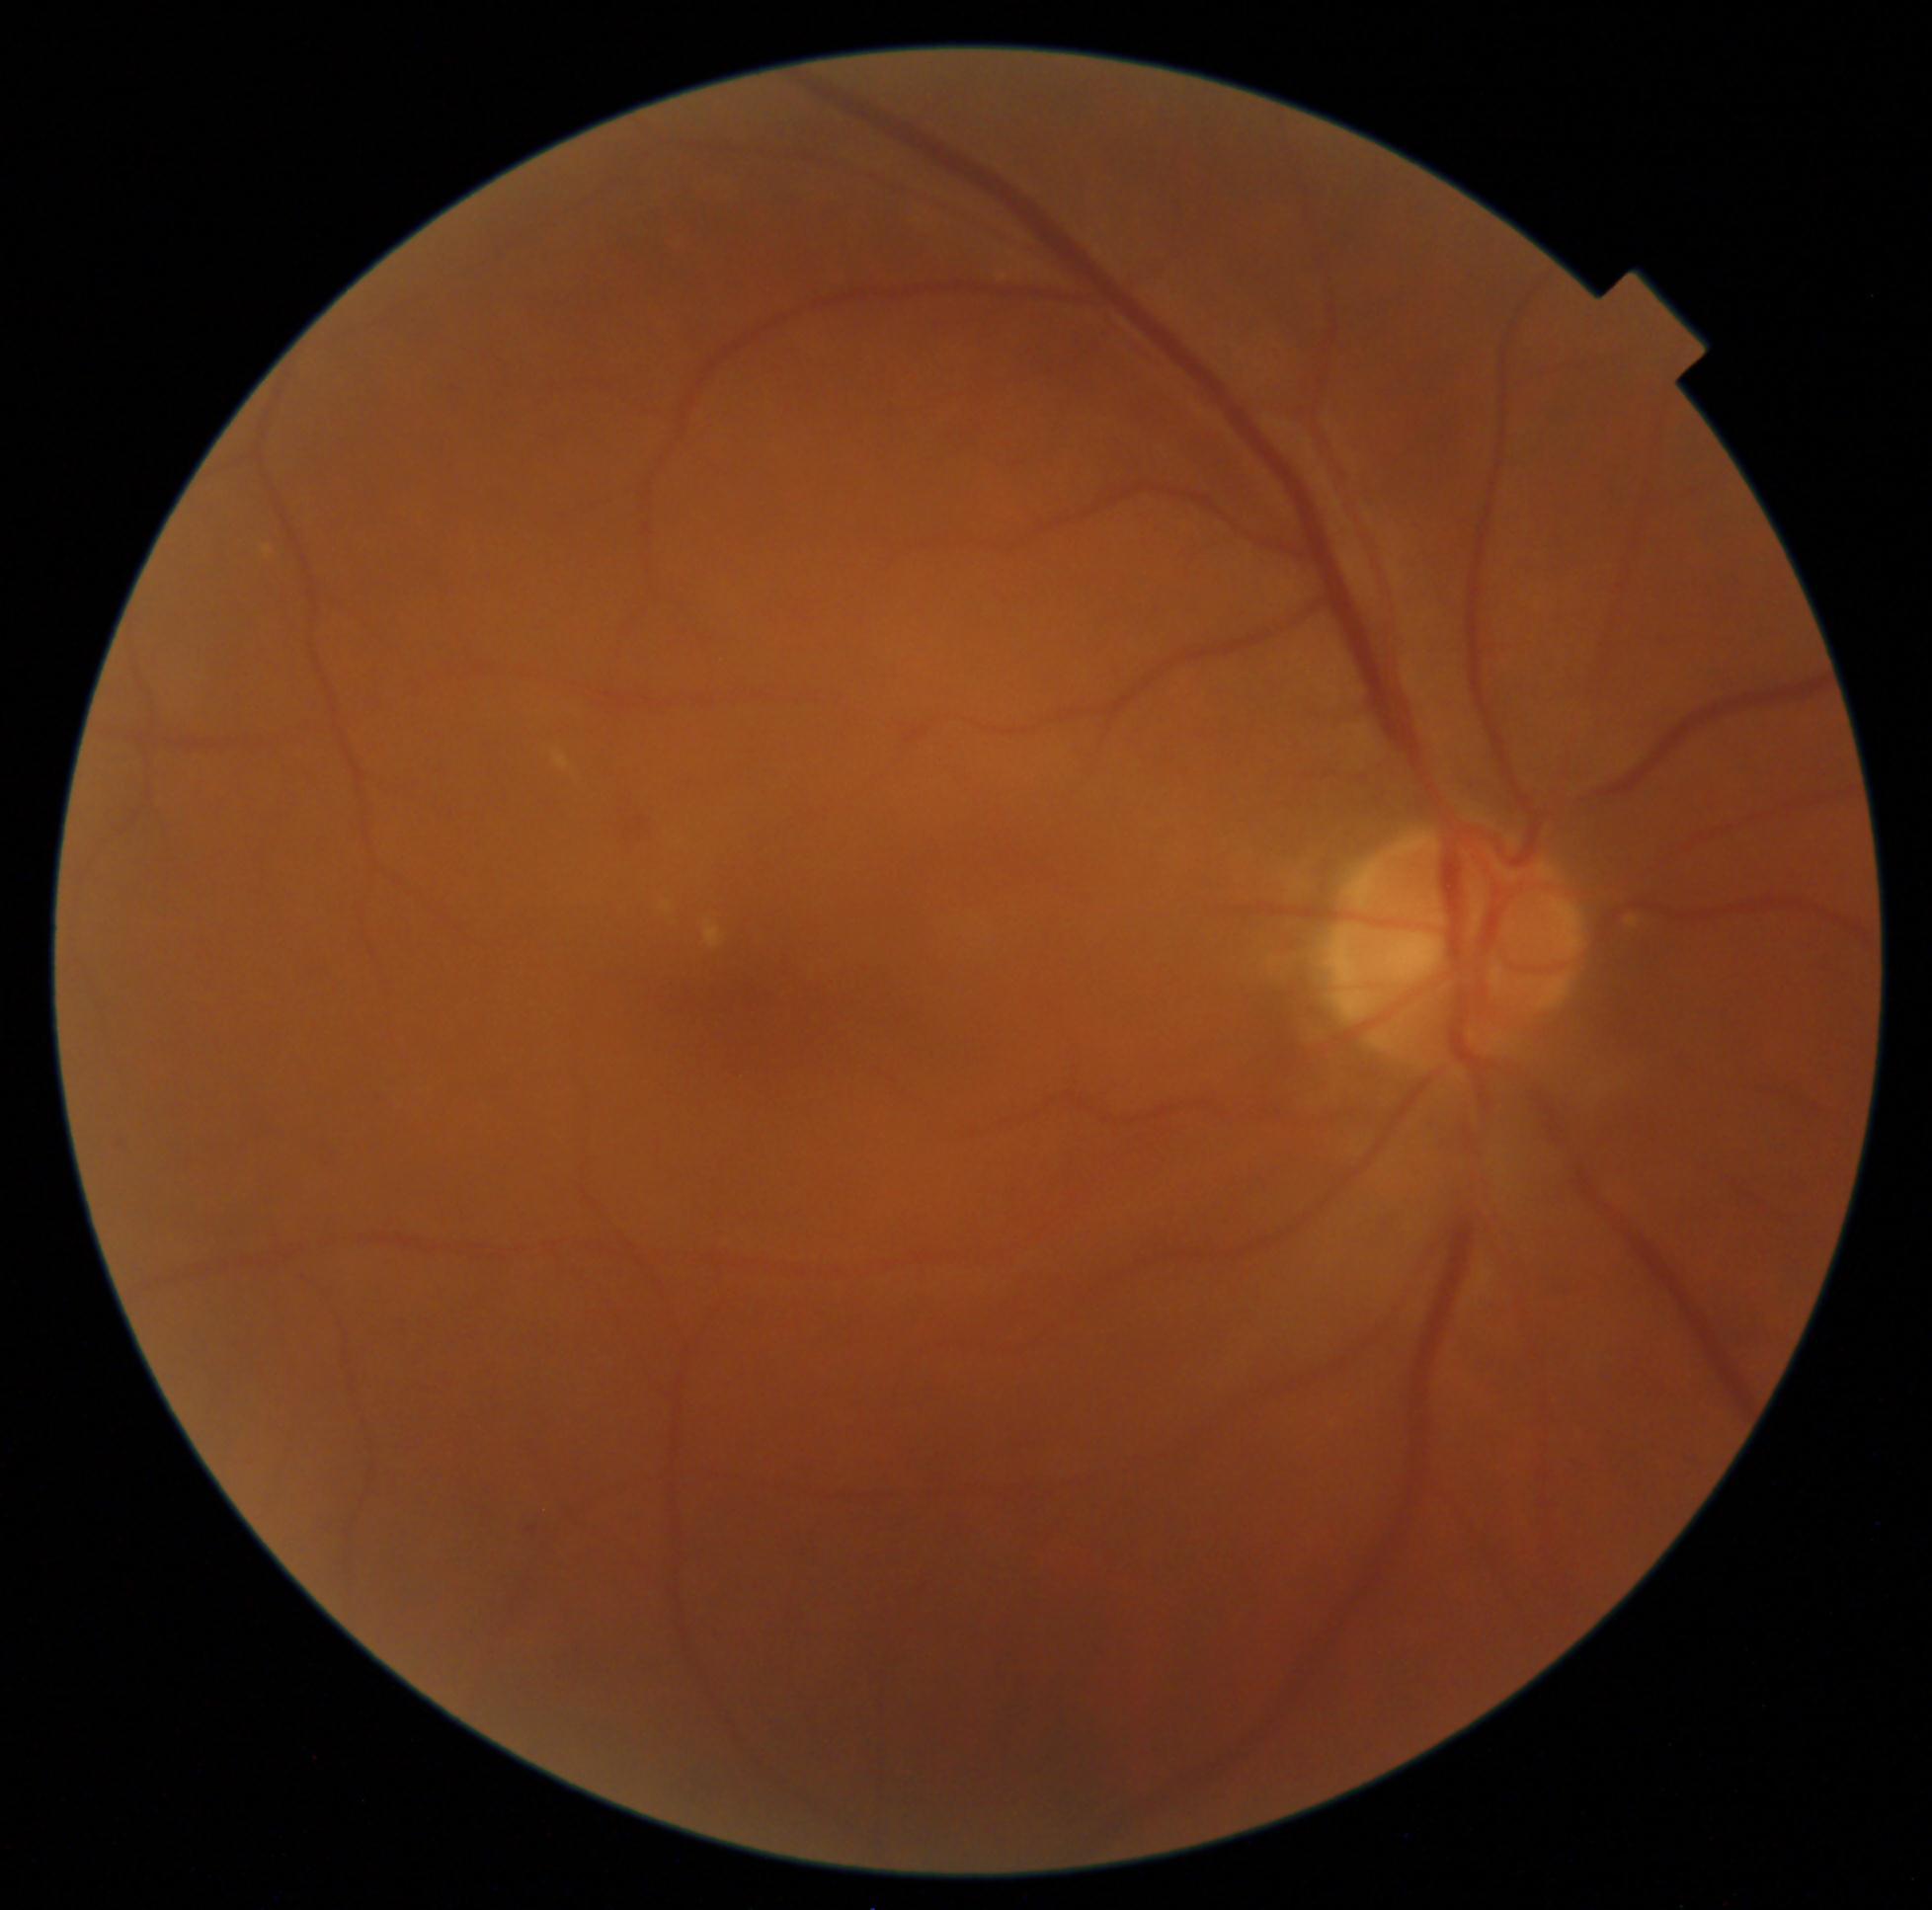

DR grade is 2.
The retinopathy is classified as non-proliferative diabetic retinopathy.